Color fundus image: 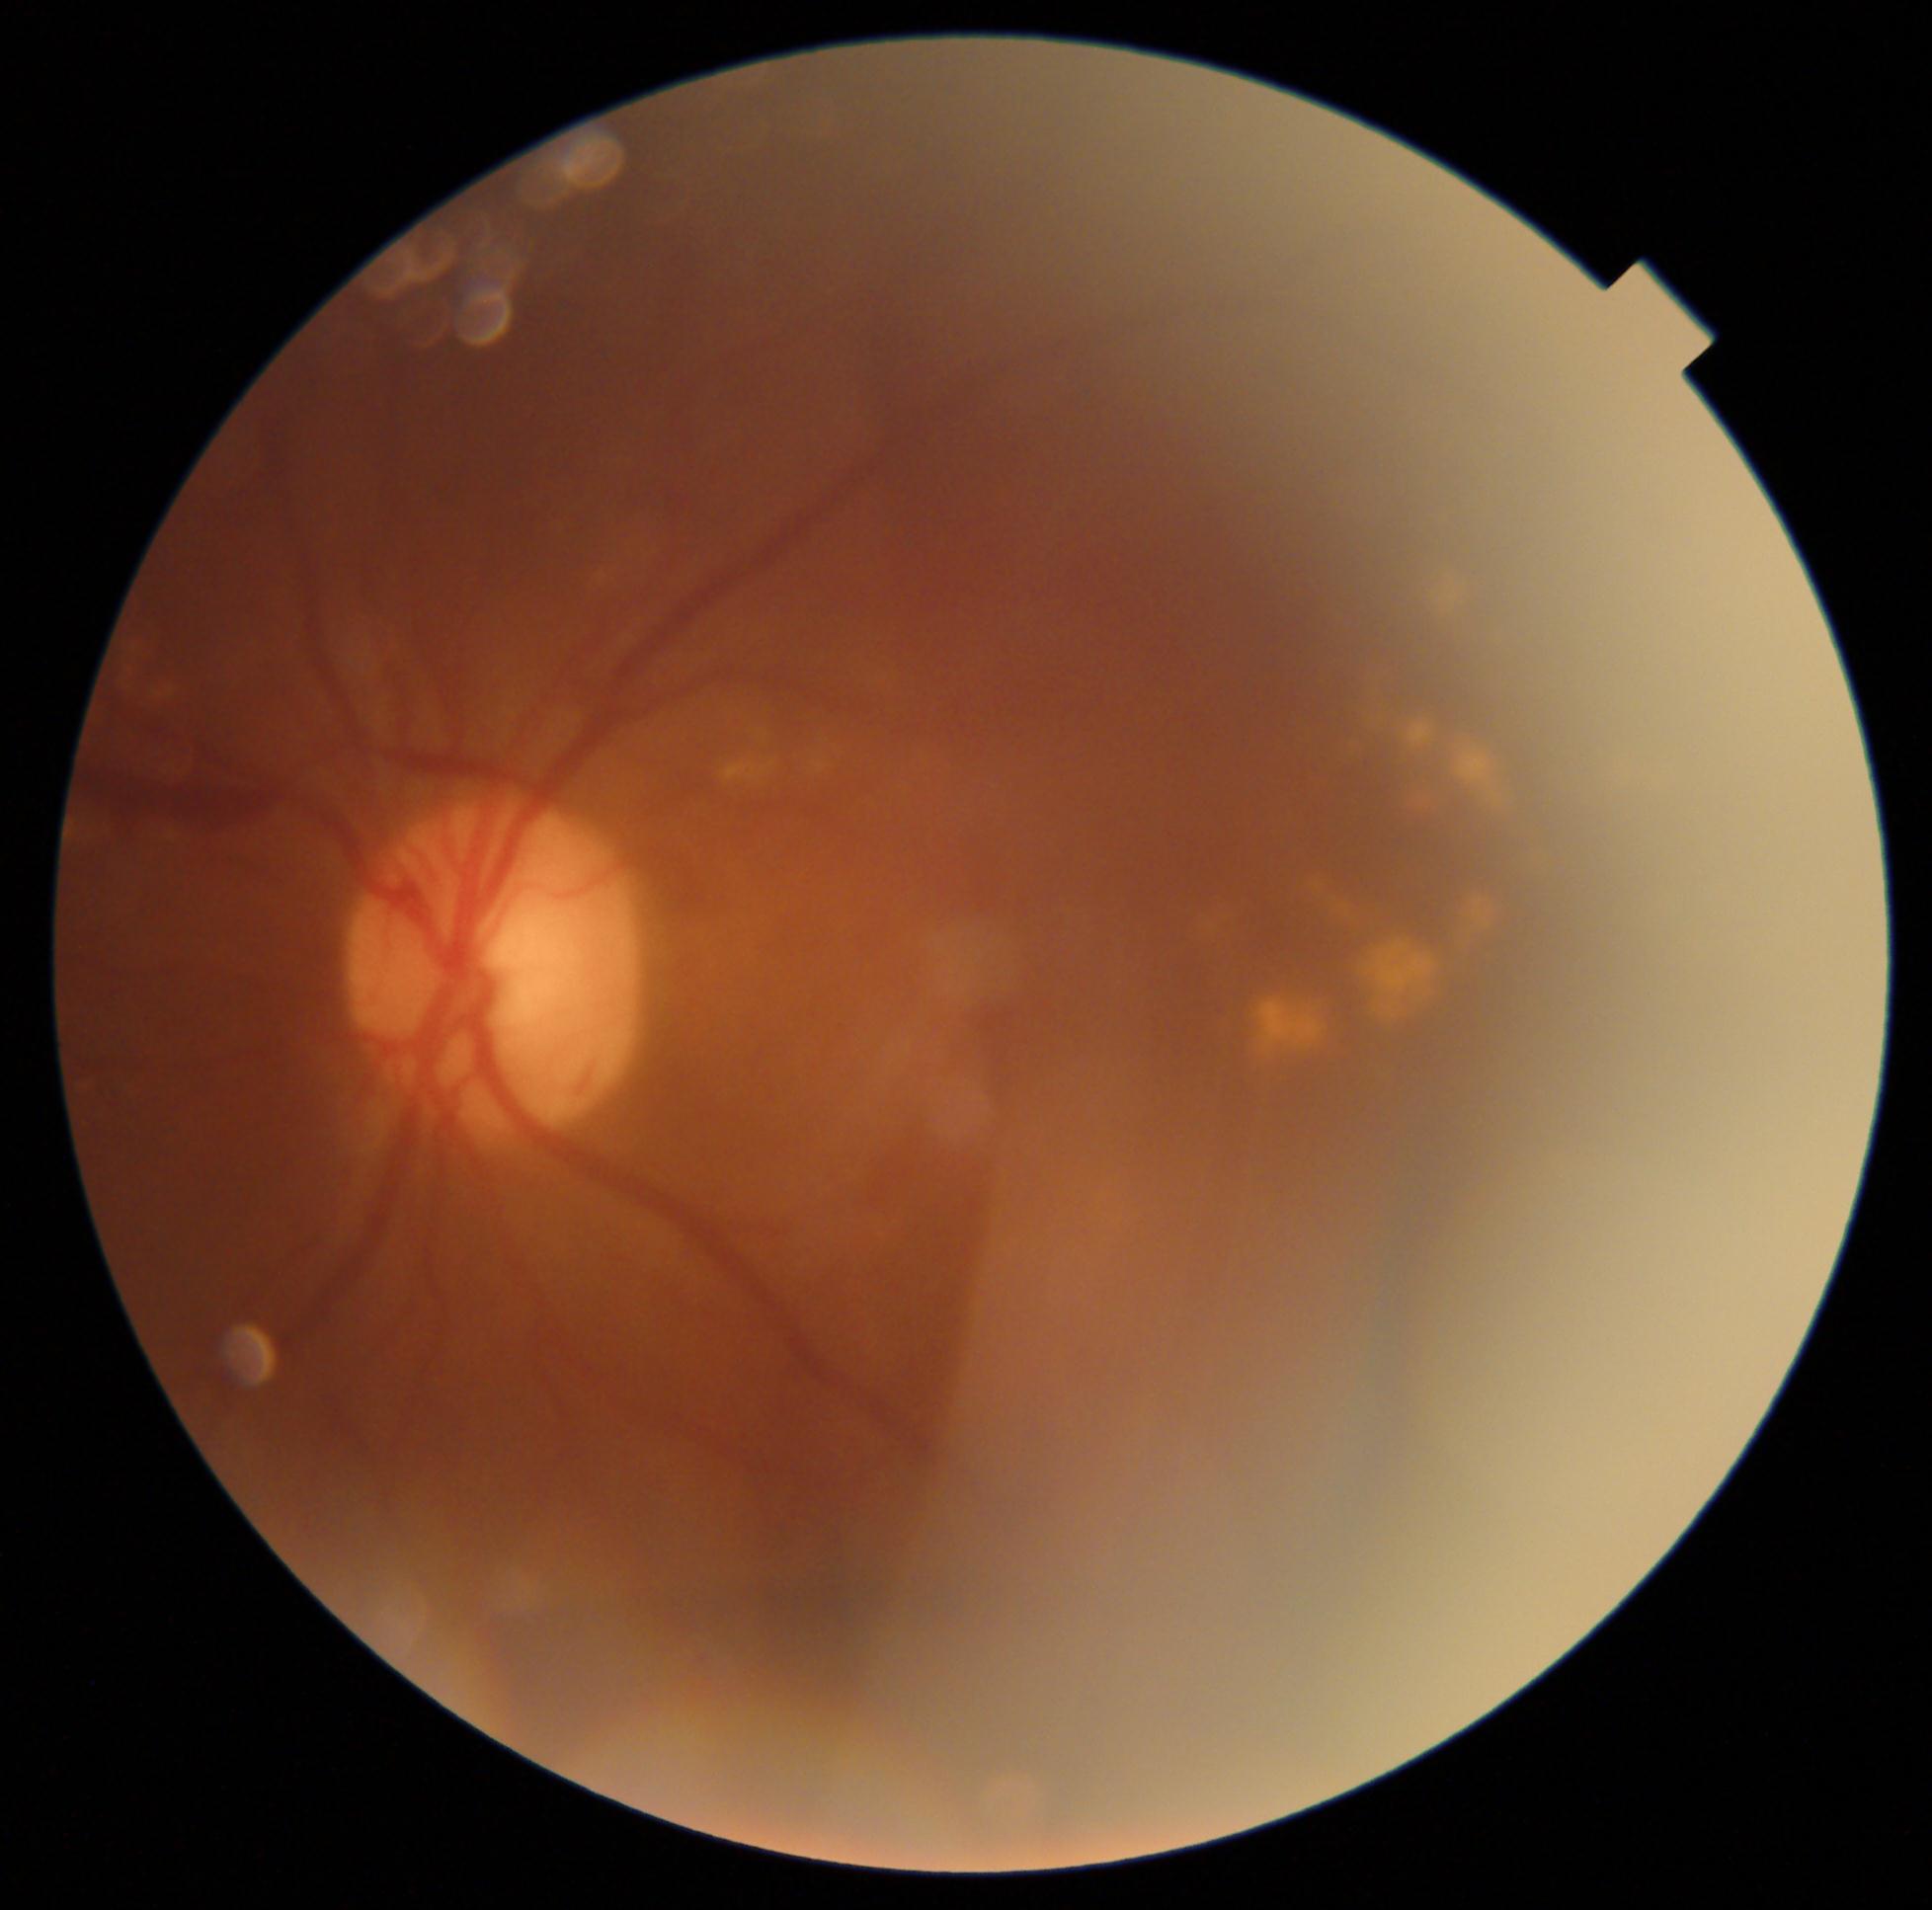

DR stage@proliferative diabetic retinopathy (grade 4) — neovascularization and/or vitreous/pre-retinal hemorrhage.